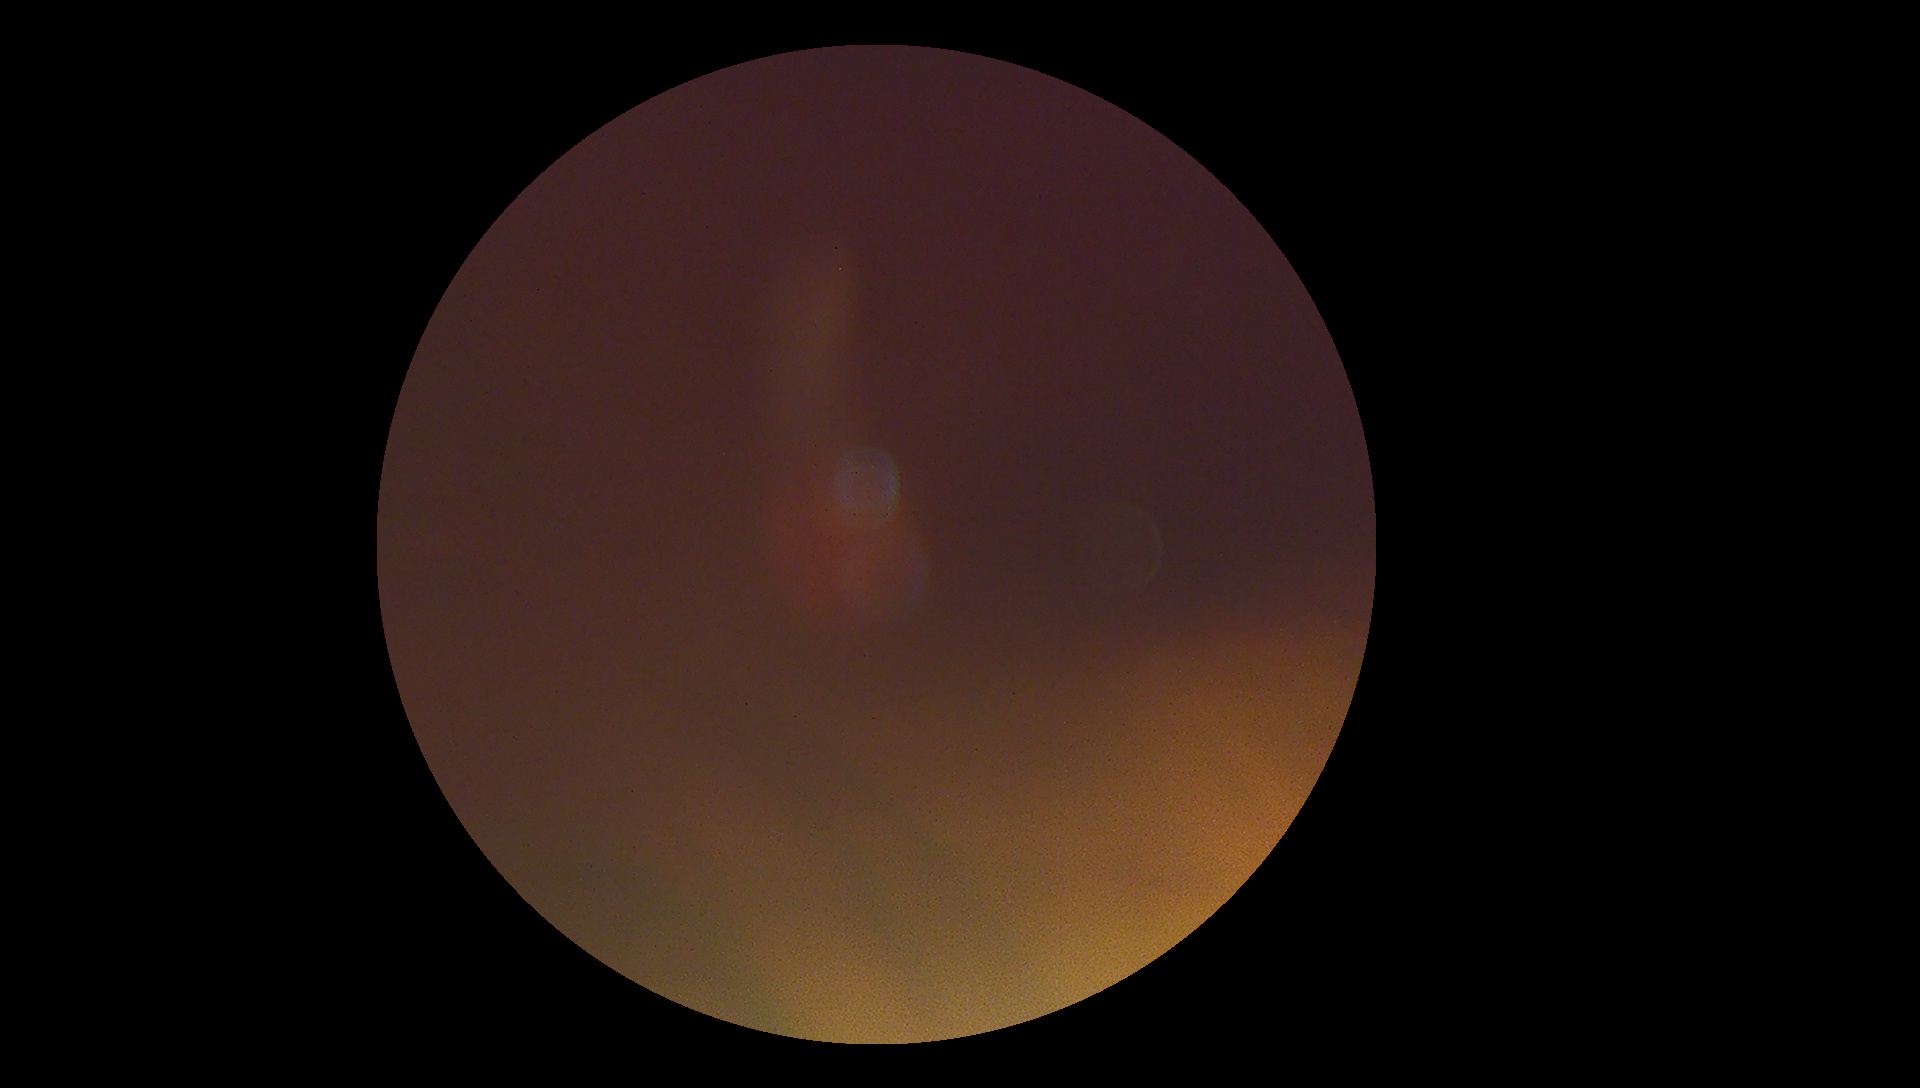

image quality: insufficient for DR assessment; retinopathy grade: ungradable due to poor image quality.